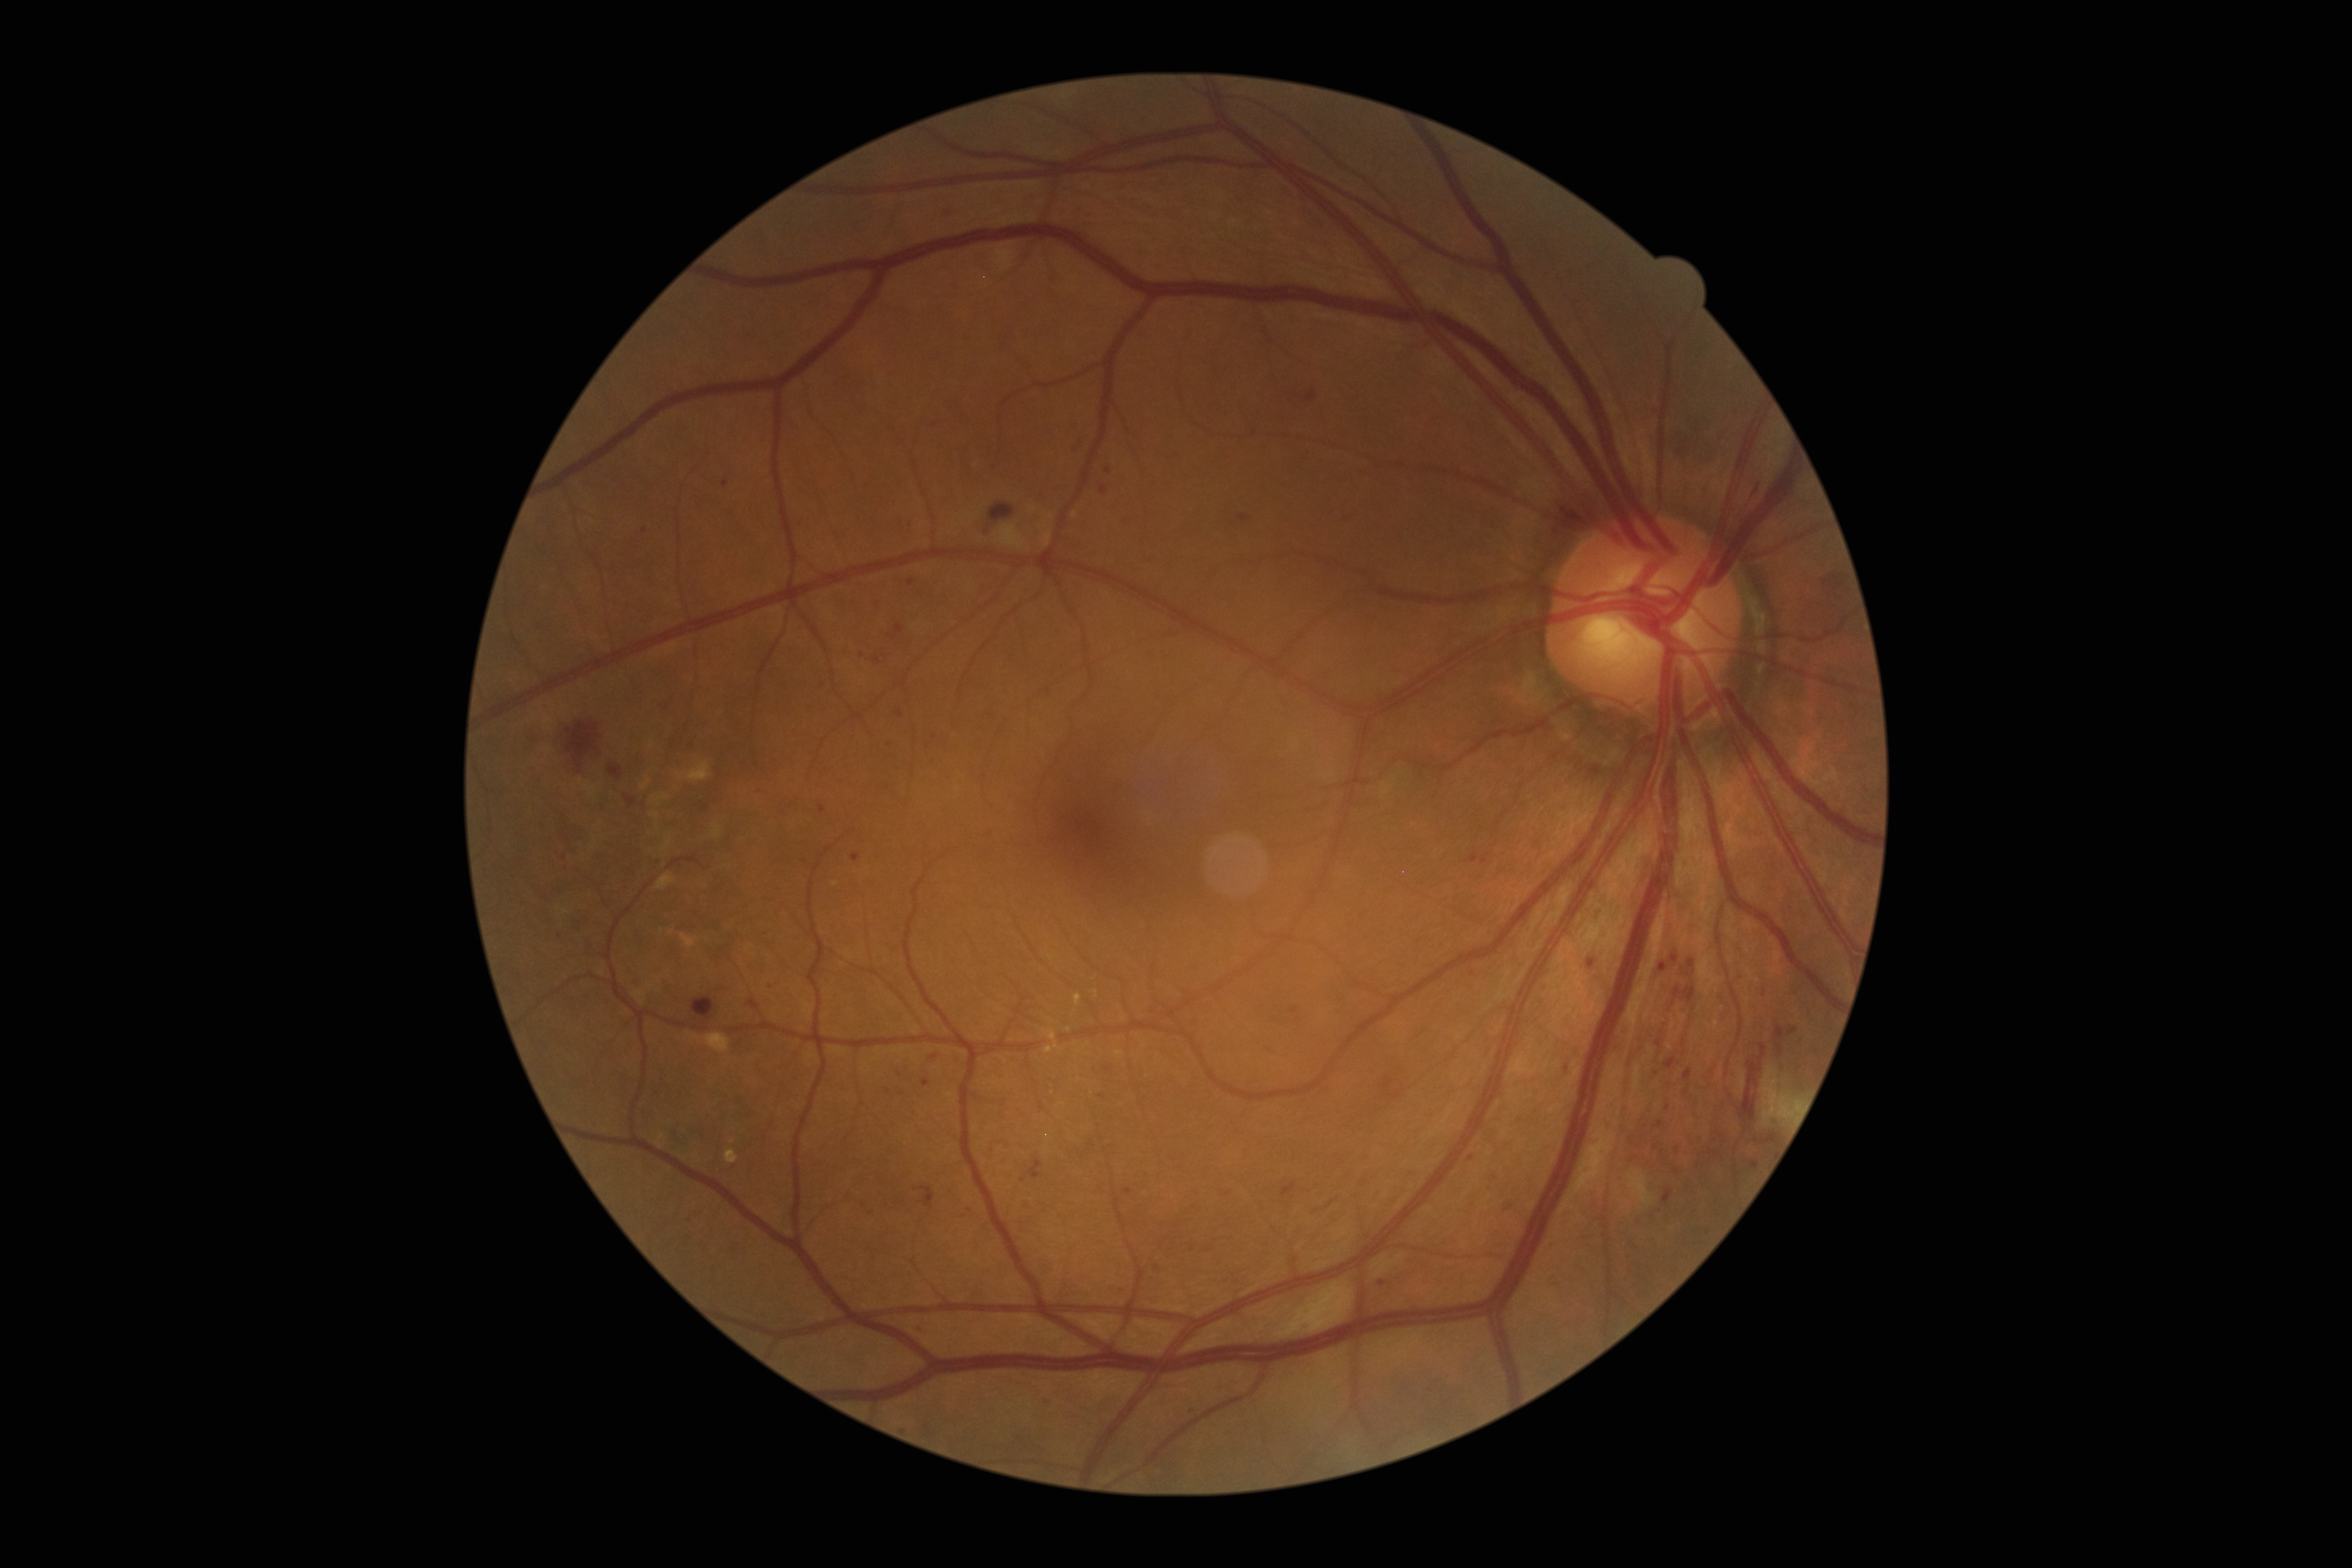 Diabetic retinopathy (DR): moderate NPDR (grade 2)
Representative lesions:
- microaneurysms (MAs) (more not shown): [left=1774, top=1025, right=1784, bottom=1041], [left=851, top=852, right=860, bottom=861], [left=1023, top=1202, right=1028, bottom=1210], [left=1028, top=1160, right=1042, bottom=1178], [left=1665, top=1057, right=1676, bottom=1069], [left=1100, top=487, right=1108, bottom=493], [left=1312, top=1204, right=1322, bottom=1215], [left=1655, top=1120, right=1663, bottom=1128], [left=1039, top=1102, right=1045, bottom=1110], [left=1685, top=1069, right=1691, bottom=1080], [left=985, top=827, right=990, bottom=838]
- Additional small MAs near x=1108, y=1068, x=565, y=857, x=1228, y=1193, x=1659, y=1042, x=973, y=1211, x=1656, y=1147, x=911, y=582, x=888, y=1090